Modified Davis grading; without pupil dilation; 848x848; 45-degree field of view; NIDEK AFC-230 fundus camera.
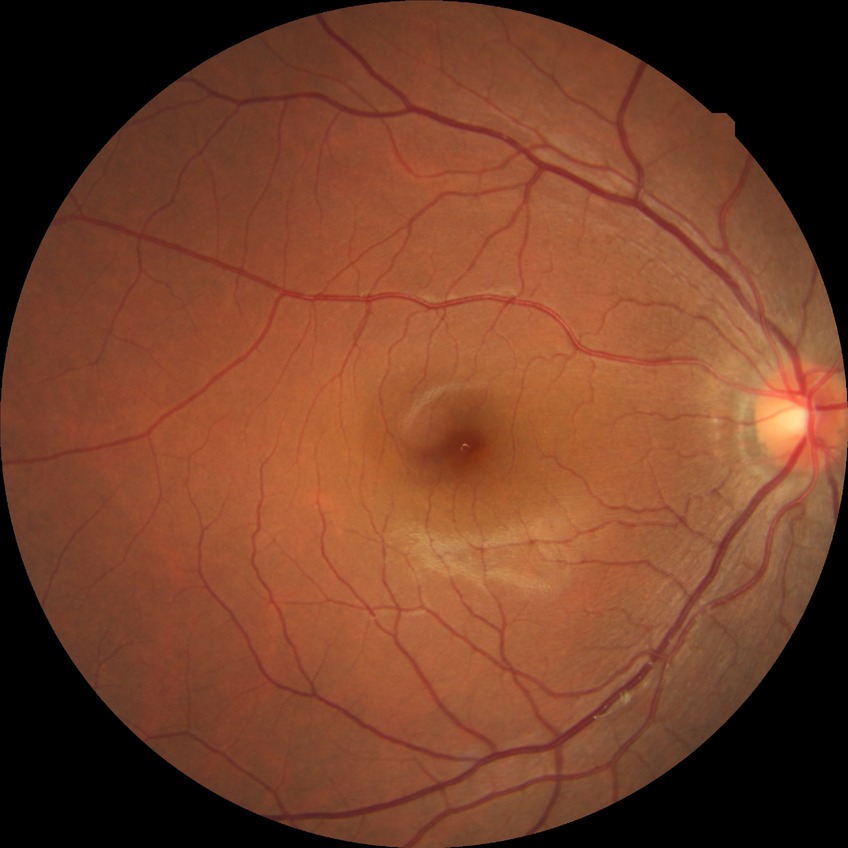 DR grade: NDR.
No apparent diabetic retinopathy.